Diabetic retinopathy graded by the modified Davis classification:
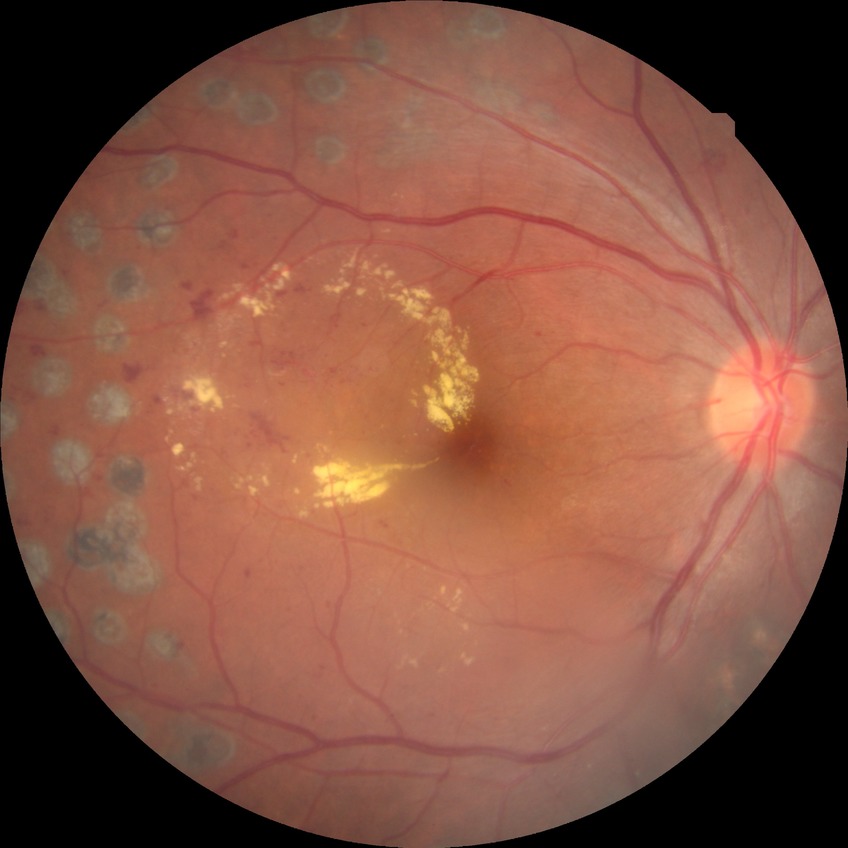
Davis DR grade: PDR.